IOP 22 mmHg (non-contact tonometry); color fundus image: 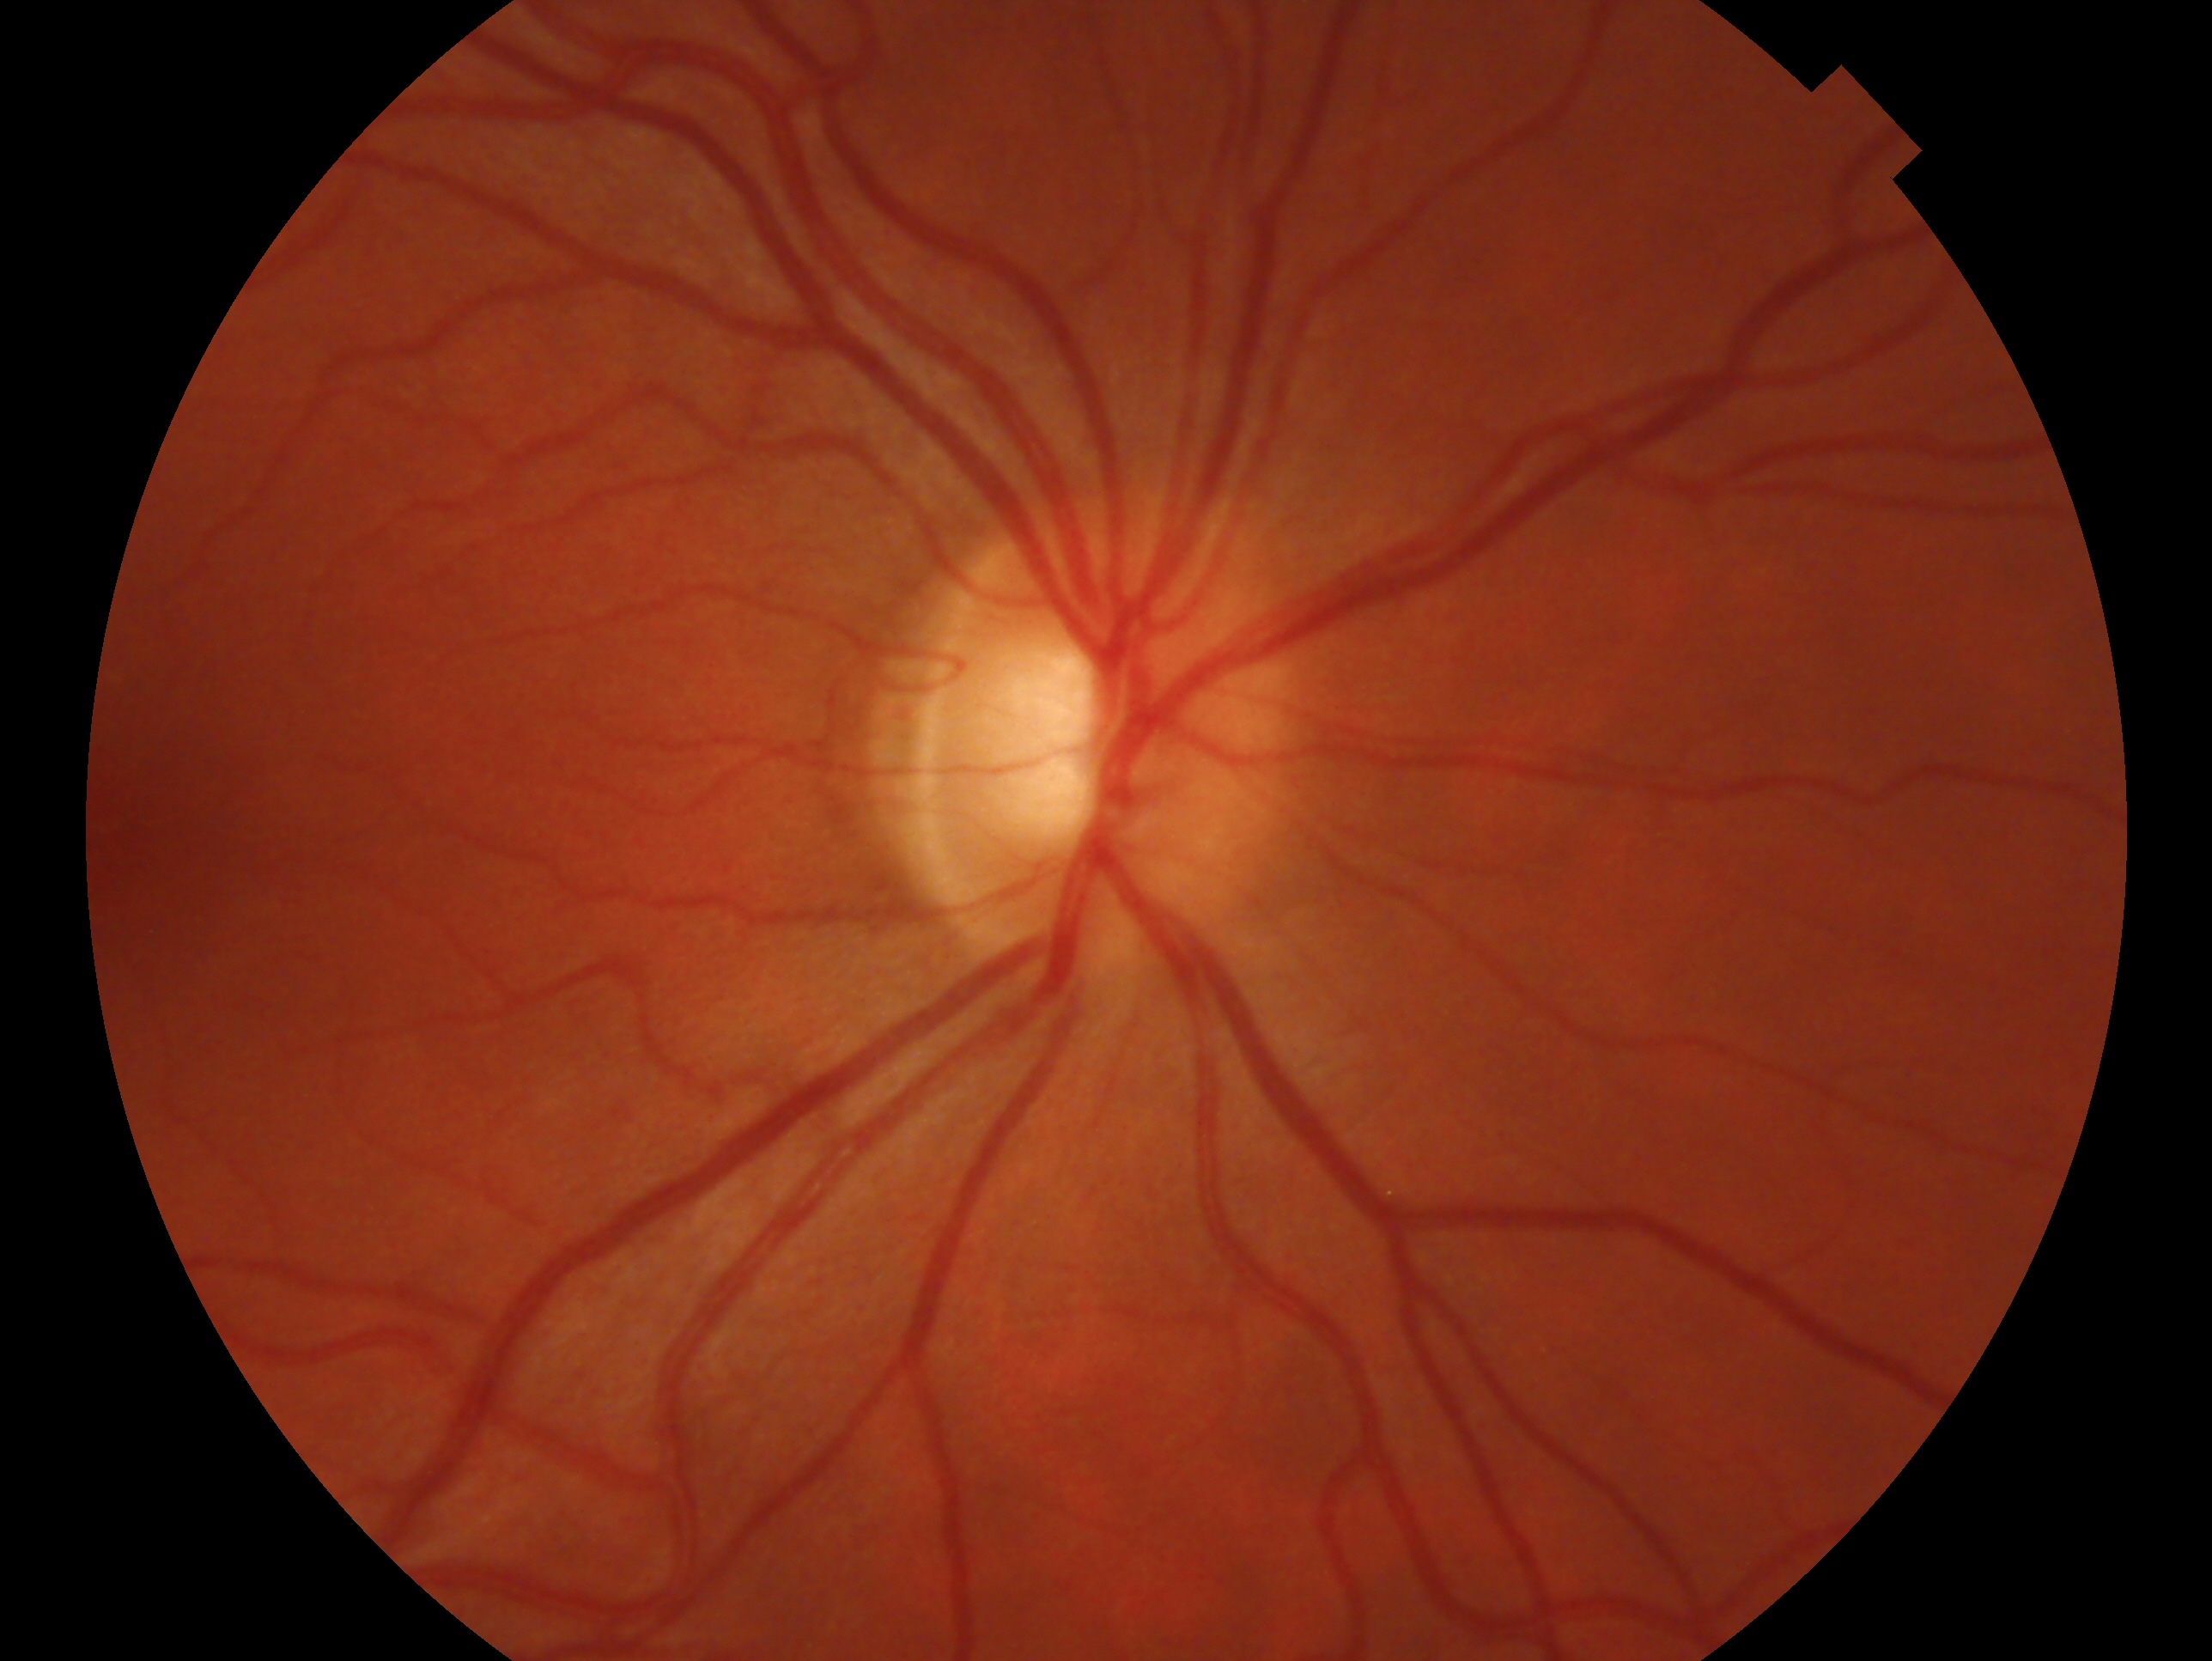
Glaucoma status — negative for glaucoma.
Imaged eye: oculus dexter.